Retinal fundus photograph, image size 2352x1568, 45-degree field of view: 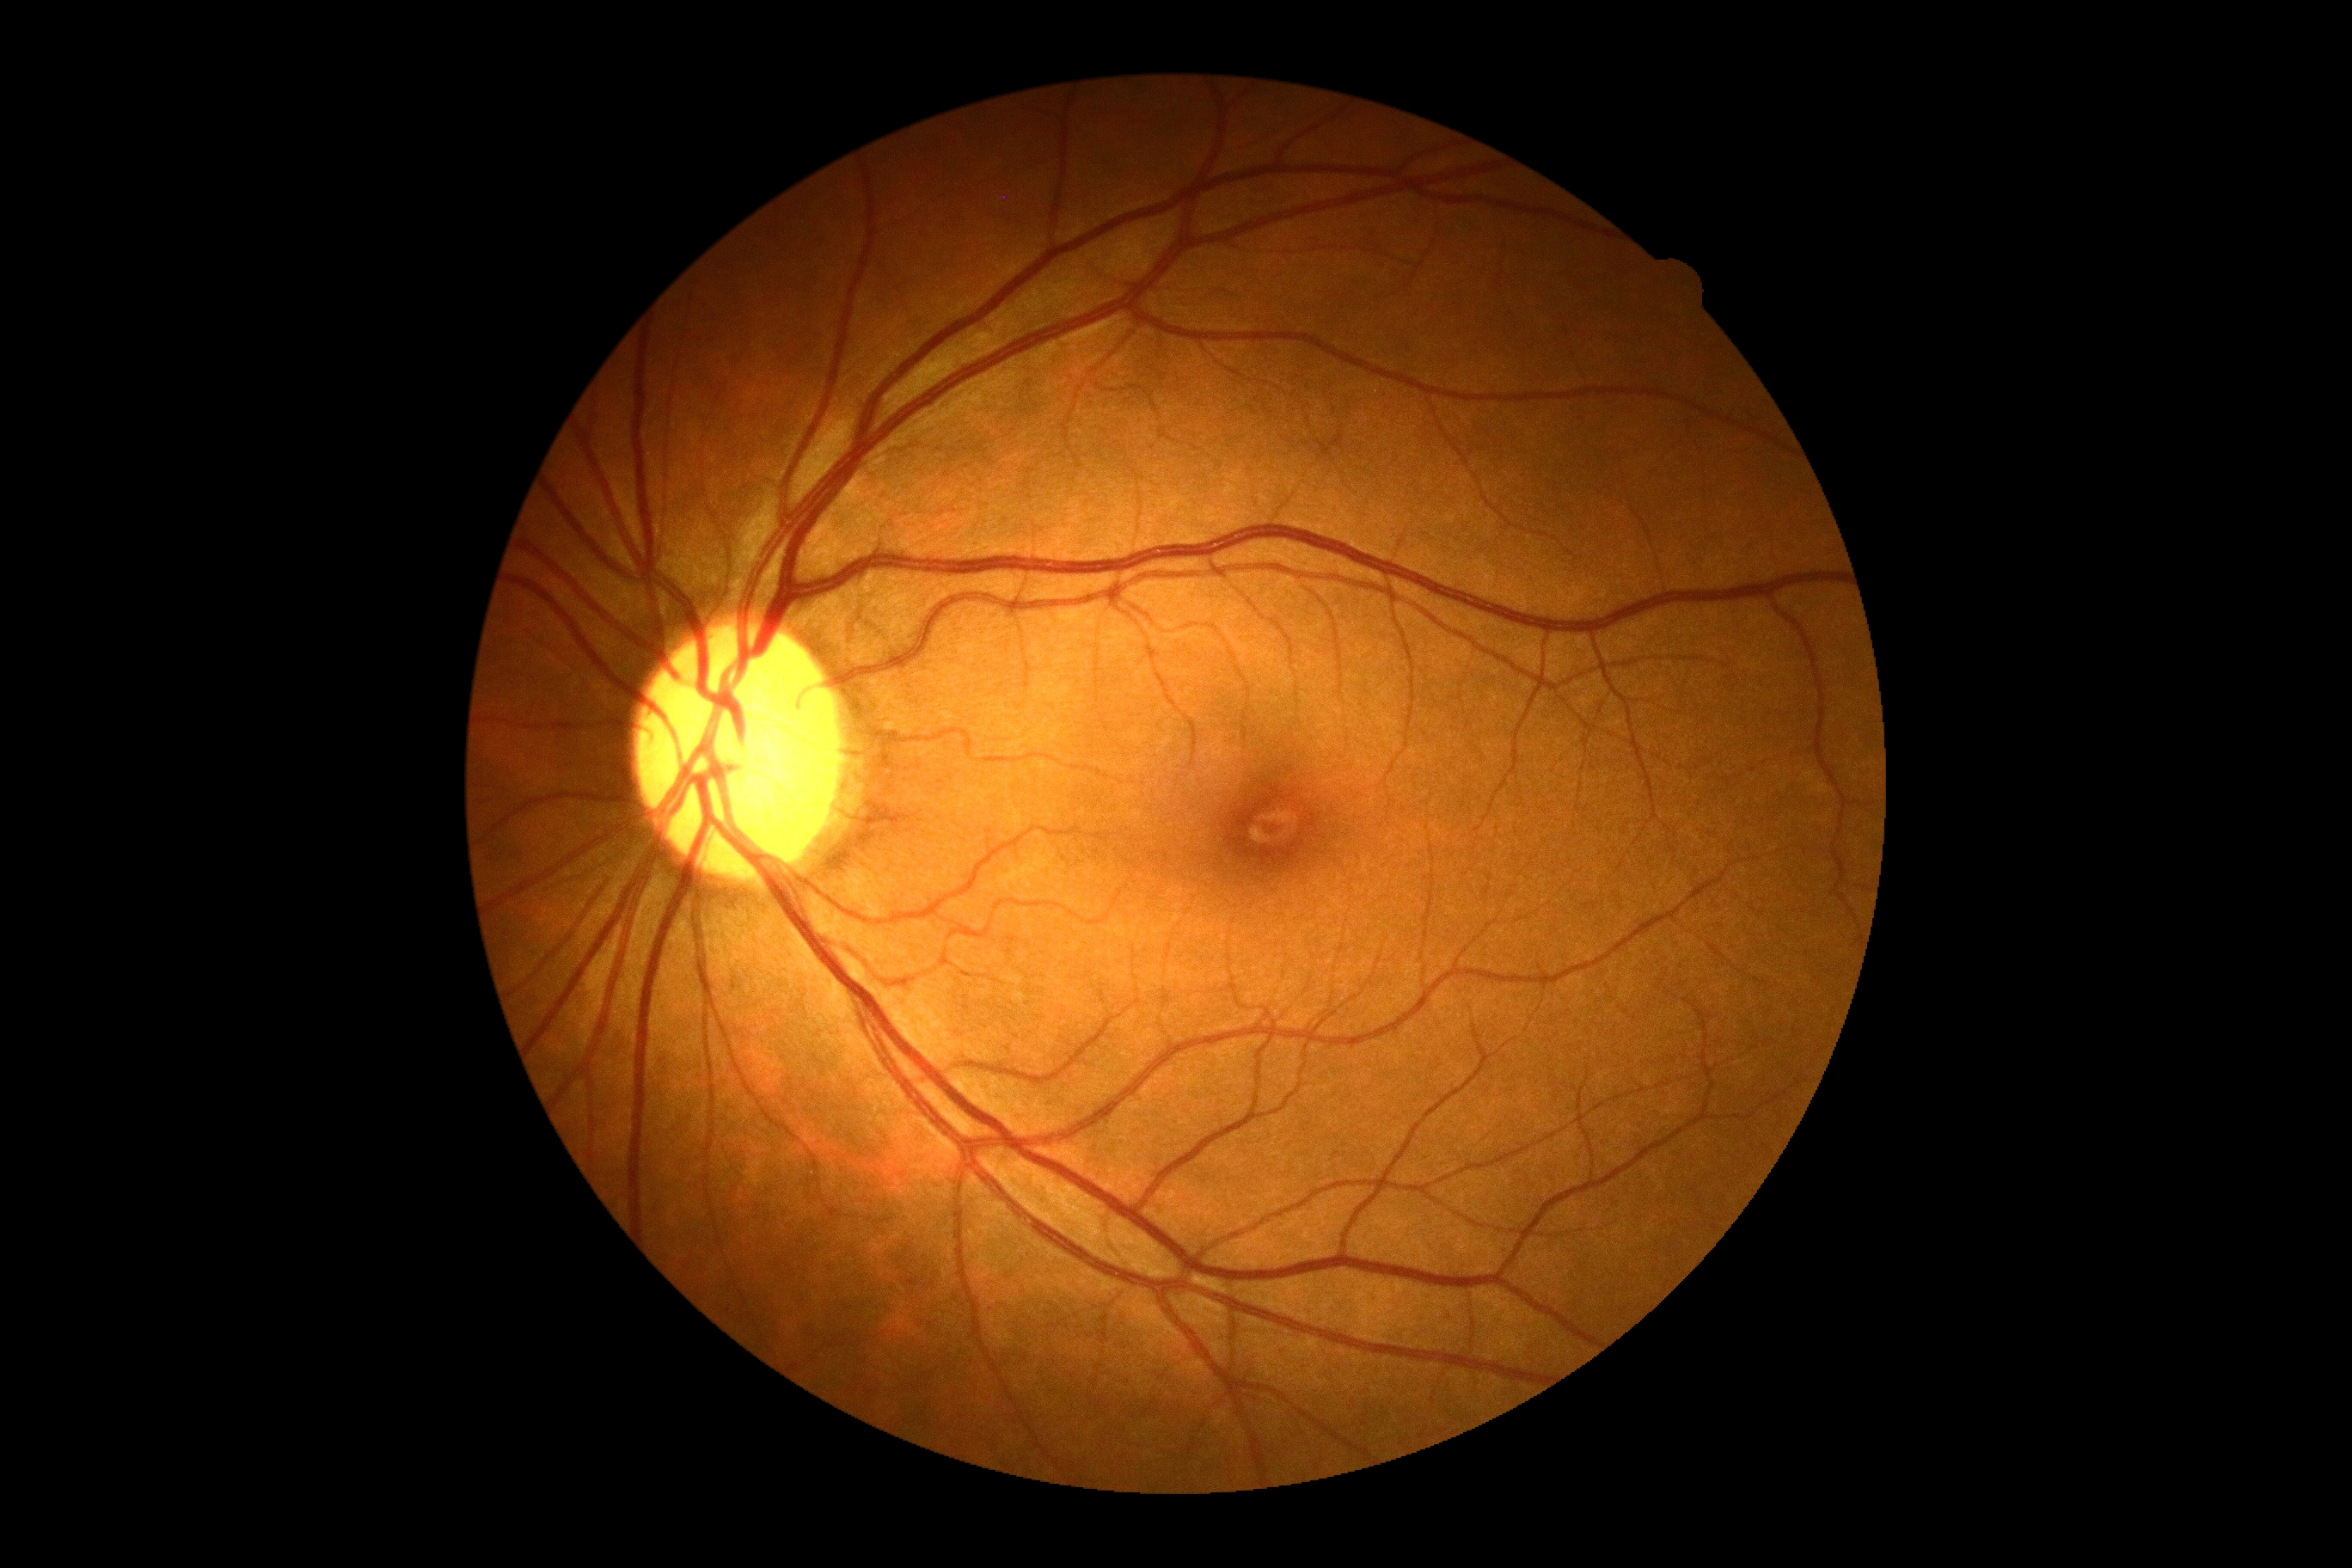 DR: 0.